Wide-field fundus photograph of an infant · 1440 x 1080 pixels · camera: Natus RetCam Envision (130° FOV):
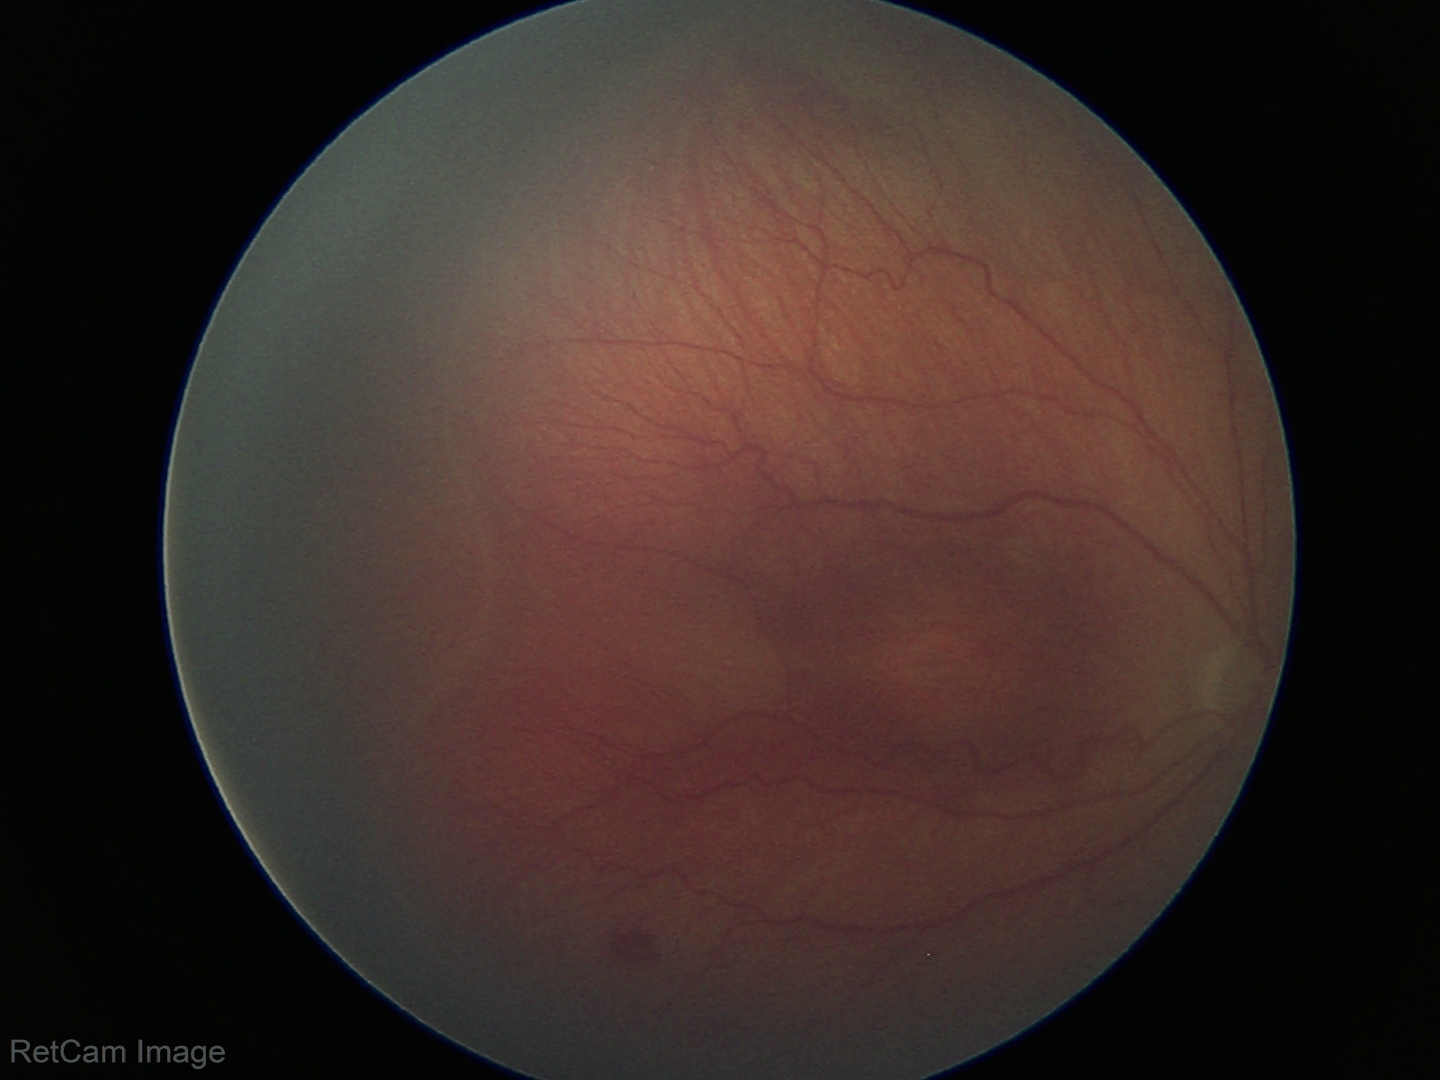

Impression: no plus disease; retinopathy of prematurity (ROP) stage 3.